848x848px. NIDEK AFC-230:
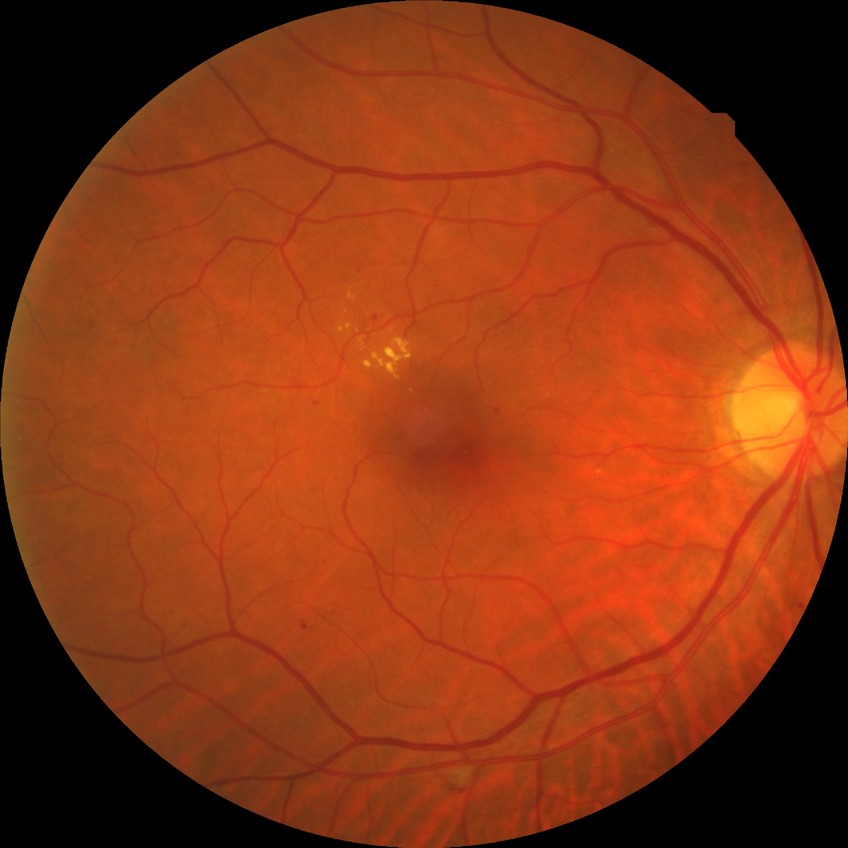

diabetic retinopathy (DR)=simple diabetic retinopathy (SDR).